848 by 848 pixels: 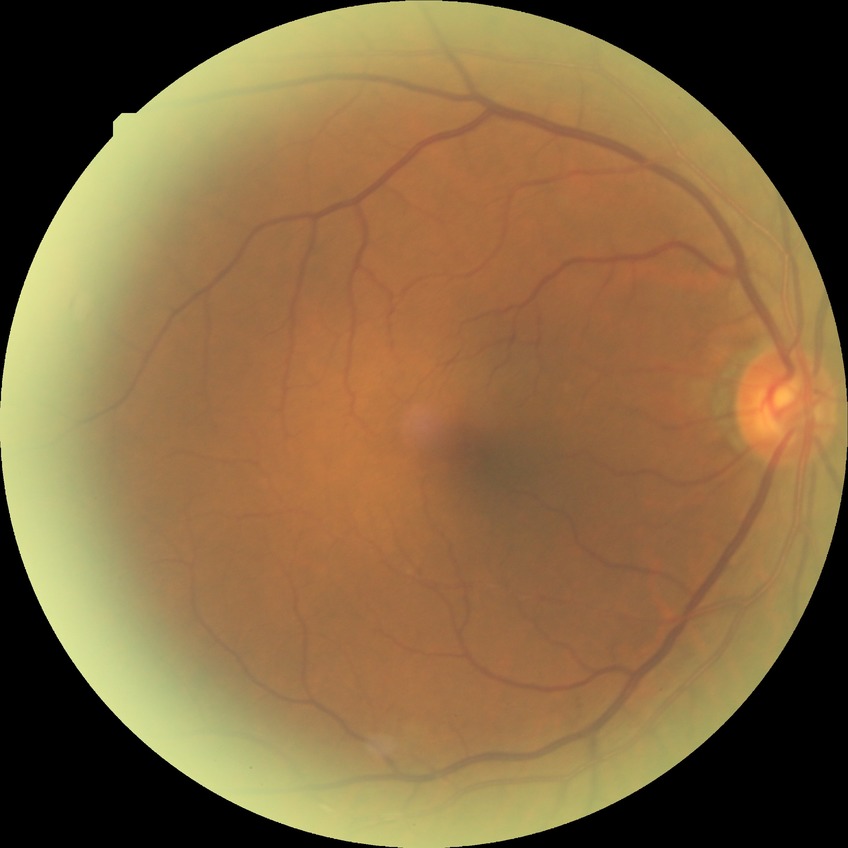
Davis grading is pre-proliferative diabetic retinopathy.